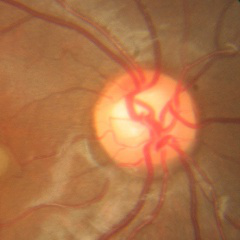 Fundus image with findings of no signs of glaucoma.